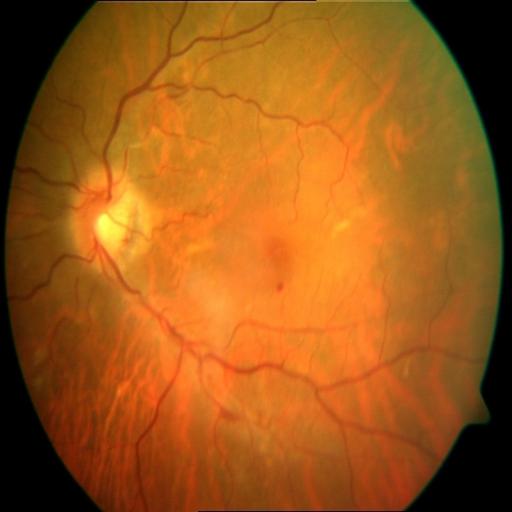 2 abnormalities. Demonstrates hemorrhagic retinopathy and myopia.